Color fundus photograph · 45° field of view.
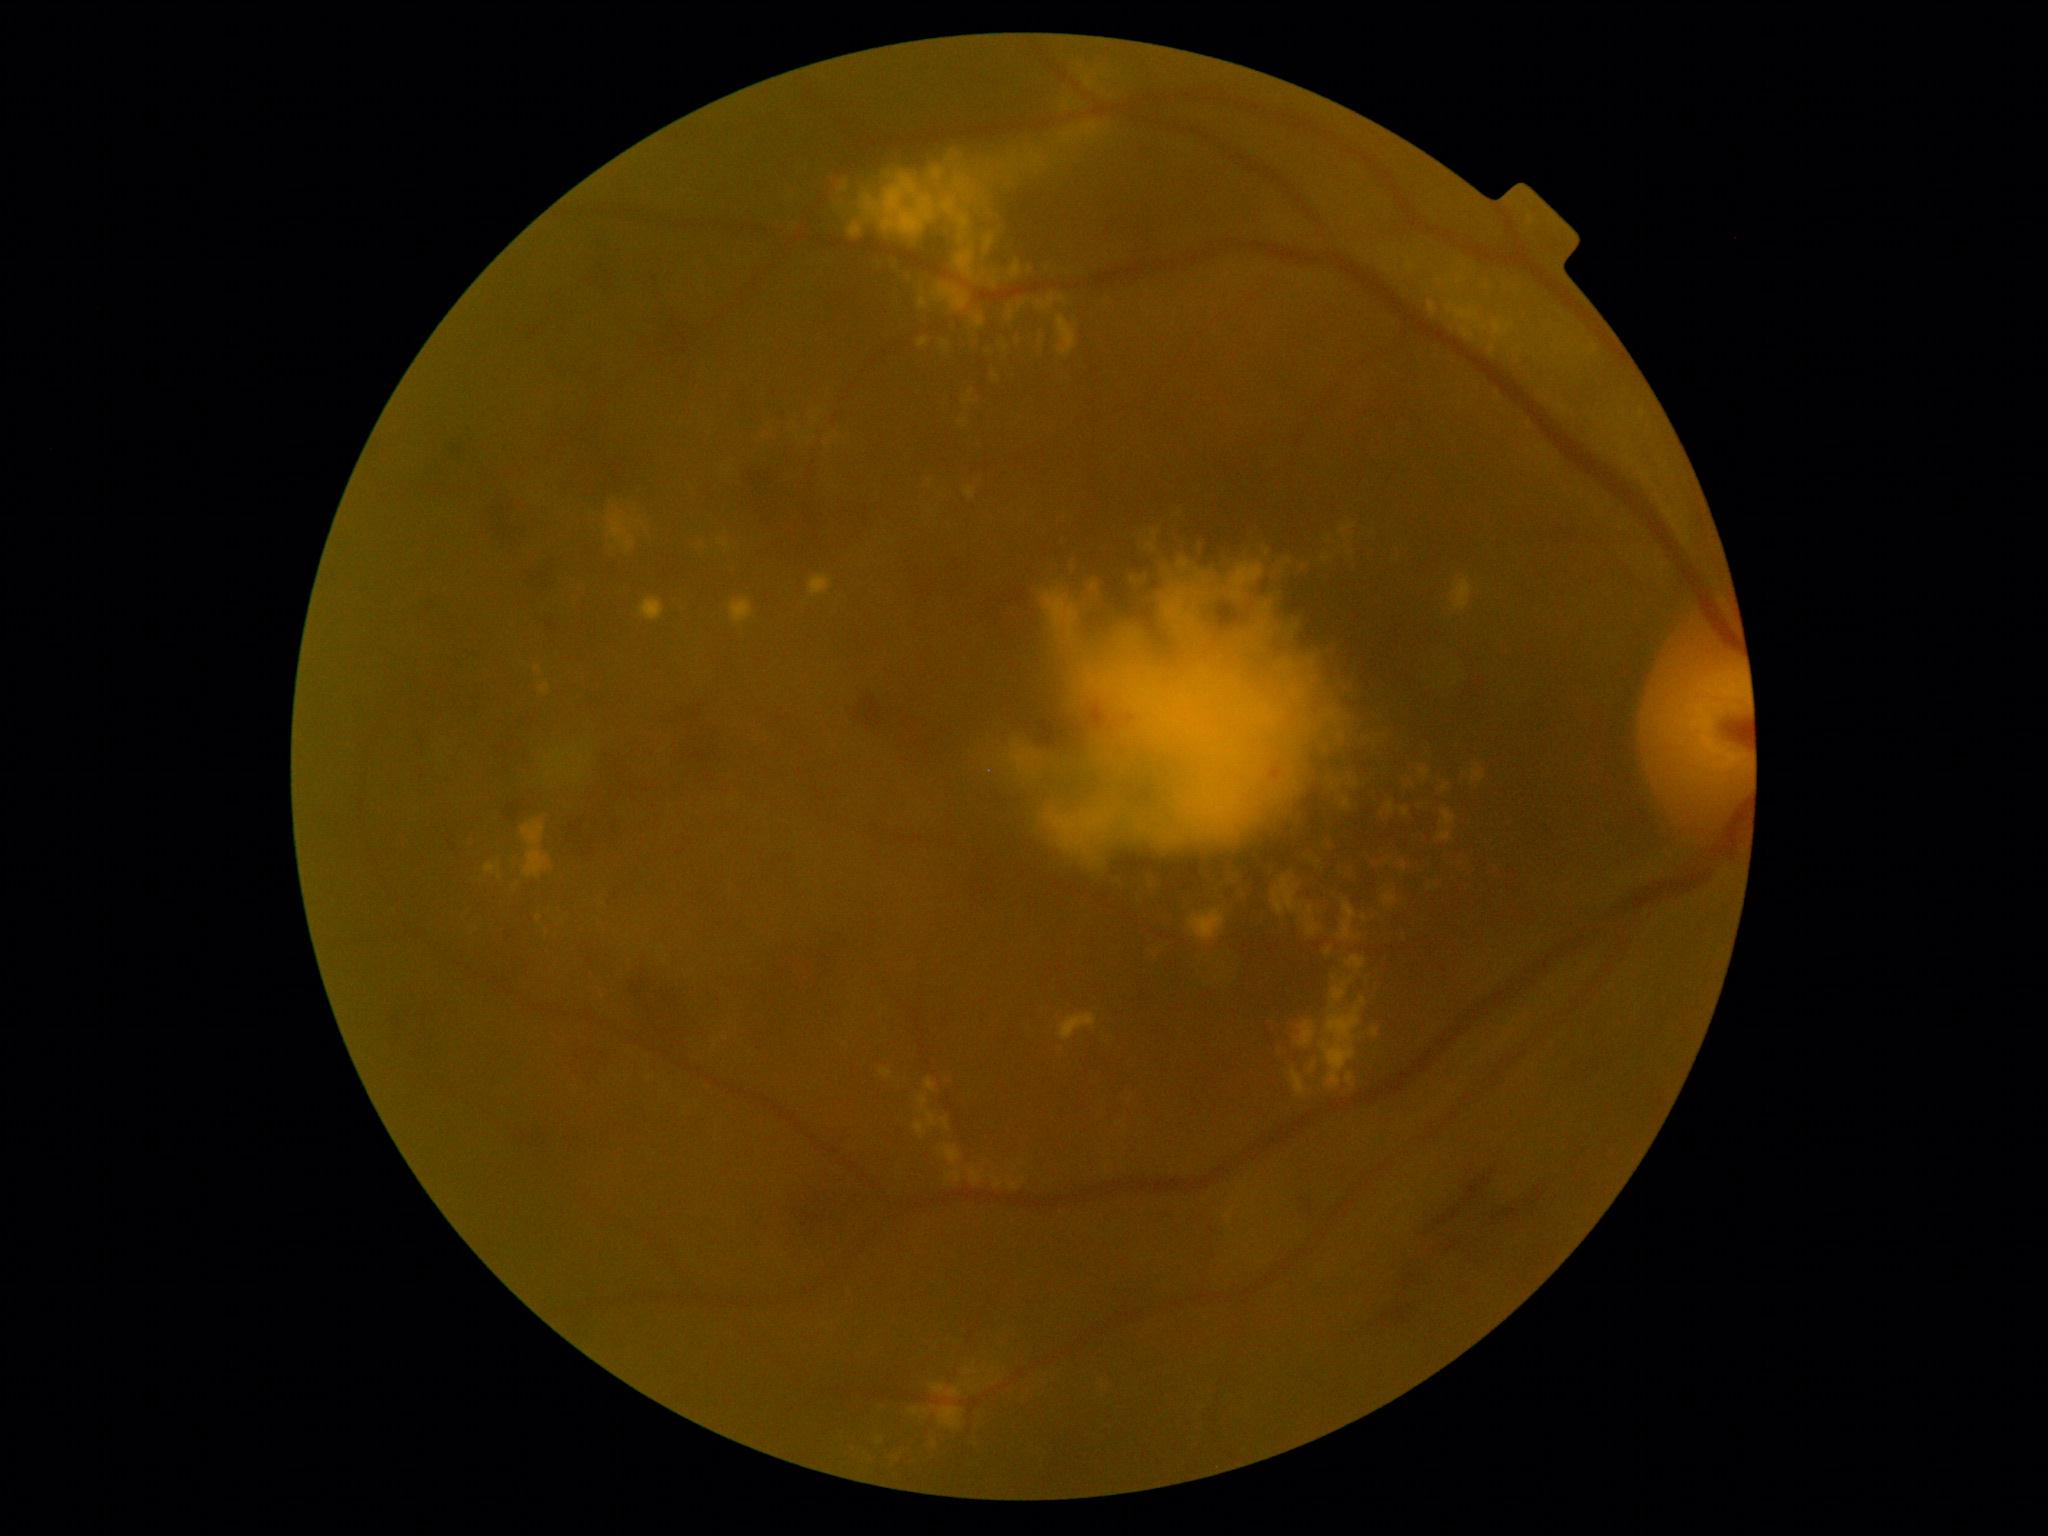 Diabetic retinopathy (DR): 2/4
Representative lesions:
hard exudates (EXs) (subset): BBox(932, 267, 971, 313) | BBox(1476, 324, 1489, 331) | BBox(939, 1075, 954, 1087) | BBox(1043, 746, 1084, 776) | BBox(640, 598, 665, 621) | BBox(1267, 1016, 1282, 1038) | BBox(1325, 833, 1341, 850) | BBox(1102, 1372, 1117, 1398) | BBox(485, 864, 499, 875) | BBox(931, 219, 955, 239) | BBox(1361, 958, 1387, 994) | BBox(1331, 978, 1354, 1011) | BBox(947, 1173, 962, 1181) | BBox(971, 313, 985, 328) | BBox(1086, 80, 1094, 88)
Additional small EXs near [1355, 937] | [816, 420] | [1020, 307]